45 degree fundus photograph. Nonmydriatic fundus photograph — 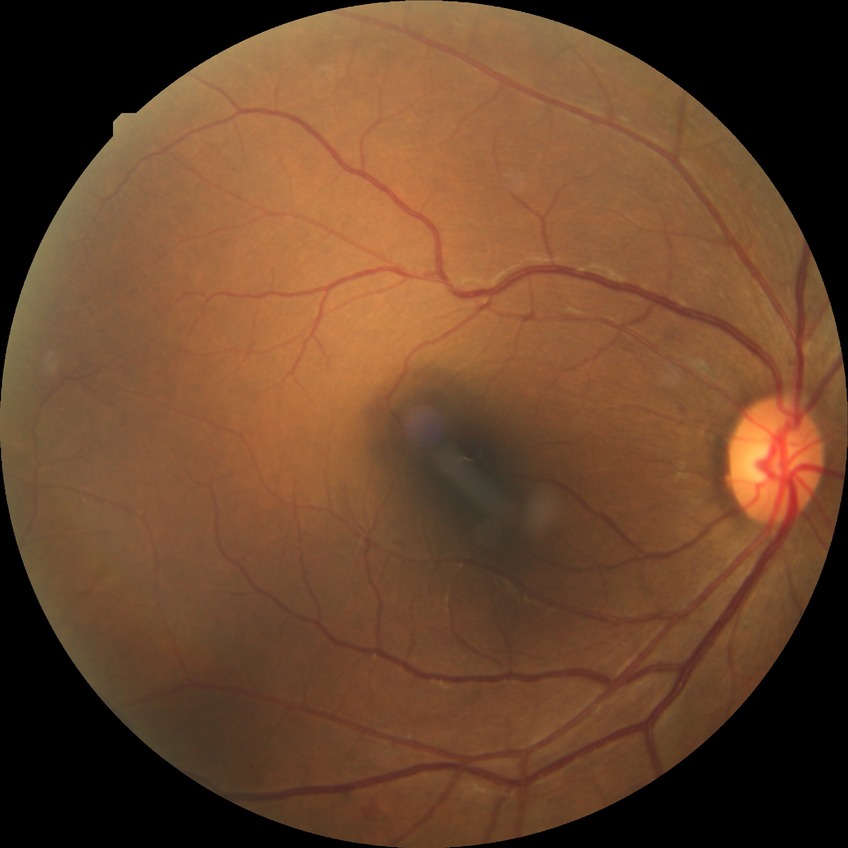 DR severity is SDR.